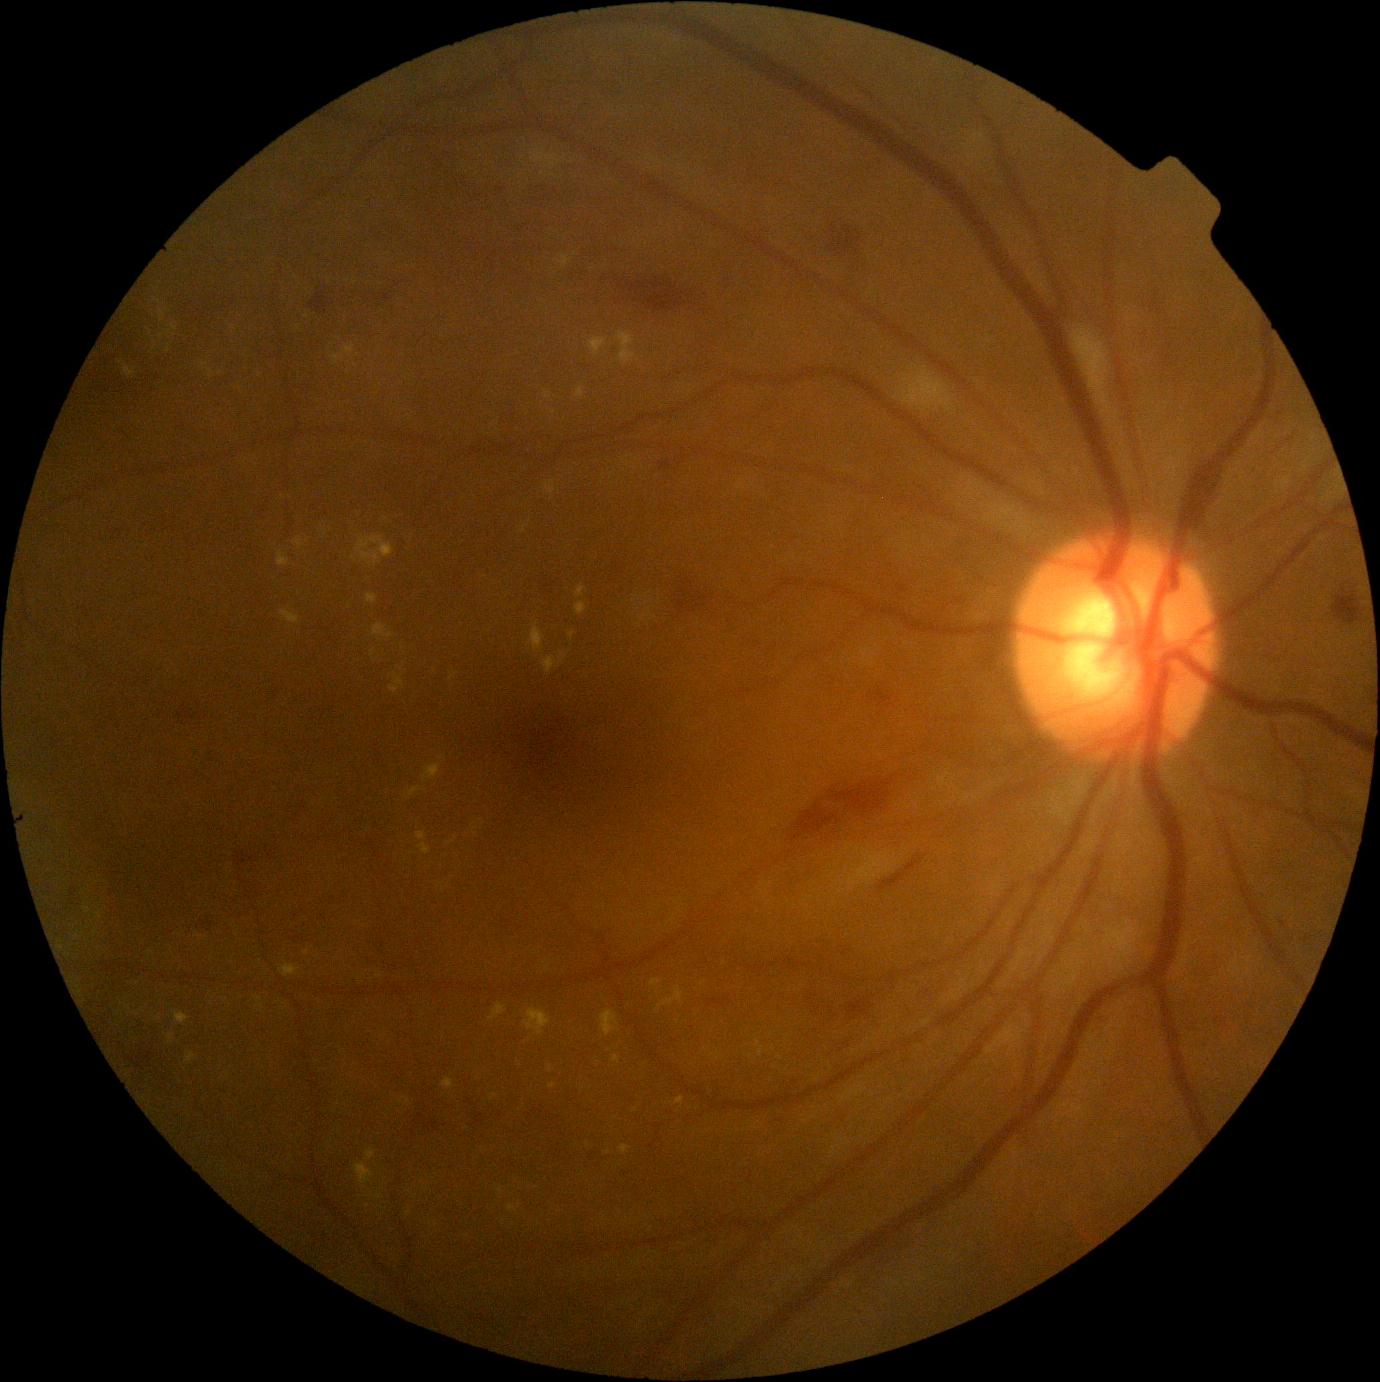 DR: moderate non-proliferative diabetic retinopathy (grade 2).